Diabetic retinopathy graded by the modified Davis classification:
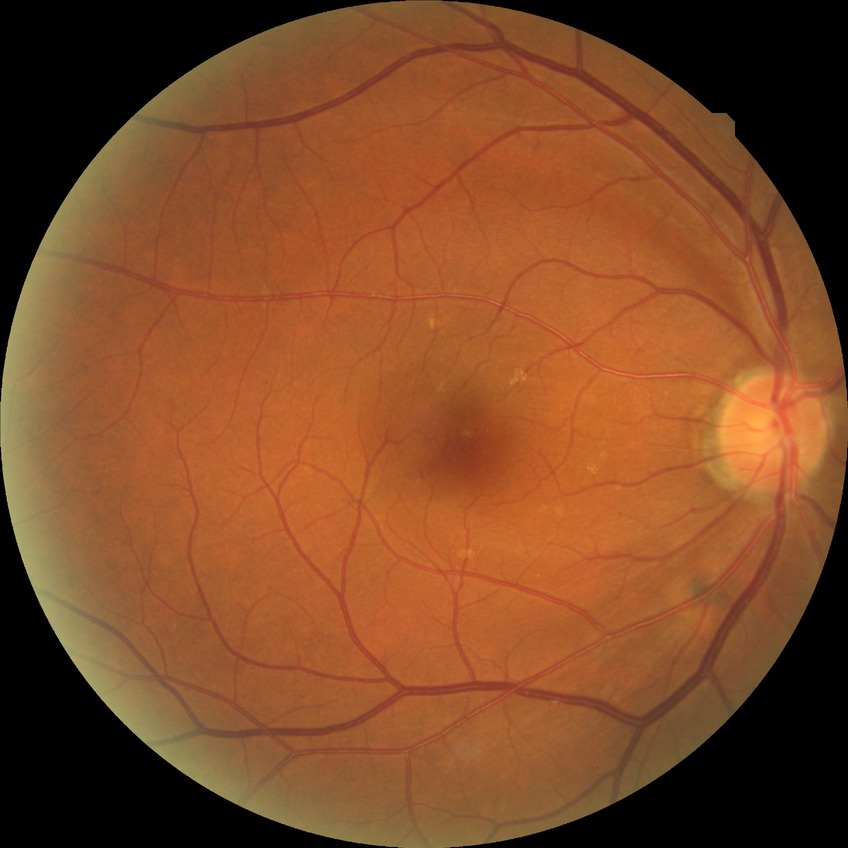
{"davis_grade": "NDR (no diabetic retinopathy)"}